Pediatric retinal photograph (wide-field) · camera: Phoenix ICON (100° FOV) · 1240 by 1240 pixels — 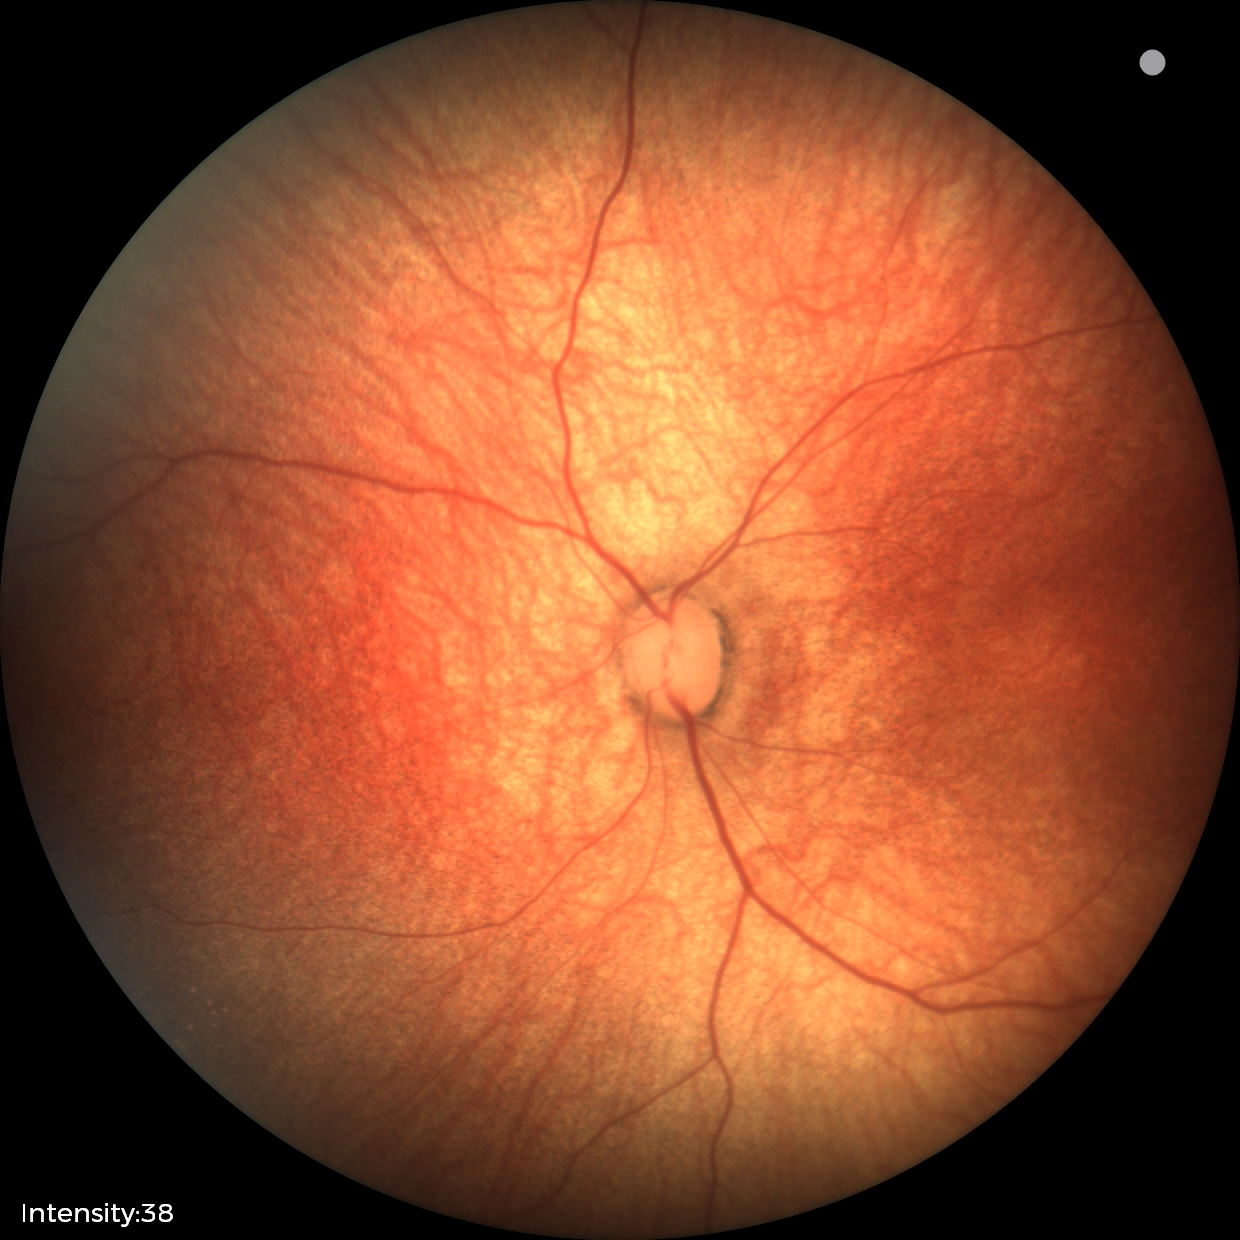

Q: What was the screening finding?
A: normal retinal appearance